Wide-field fundus image from infant ROP screening; 1240 by 1240 pixels
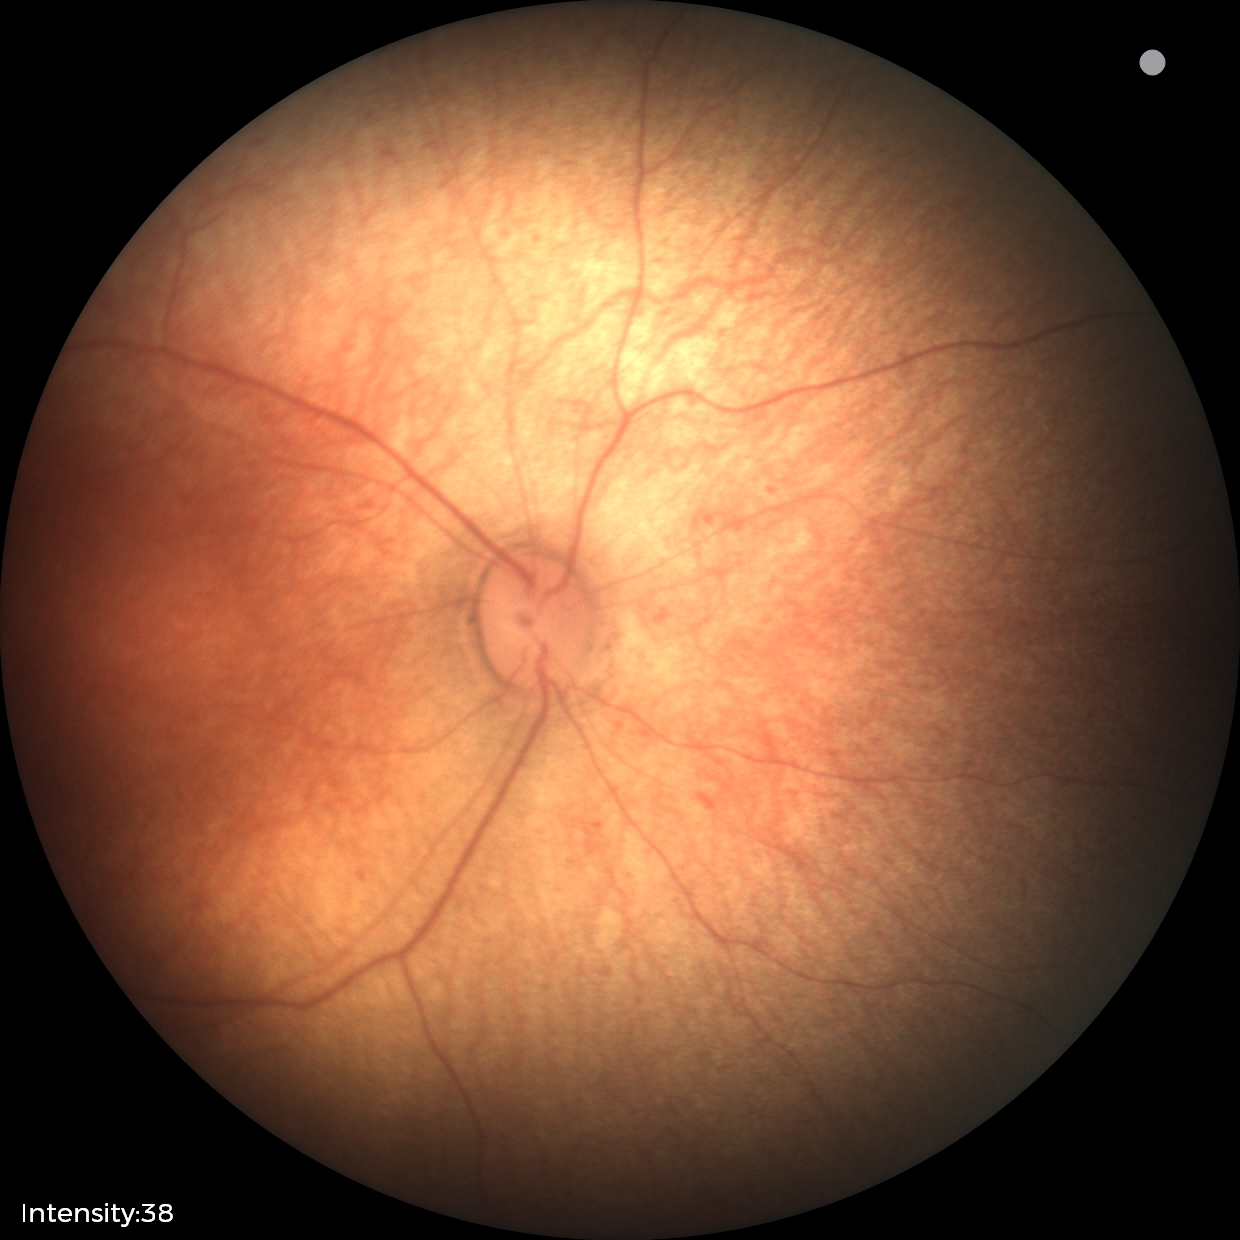
Screening diagnosis: normal fundus examination.